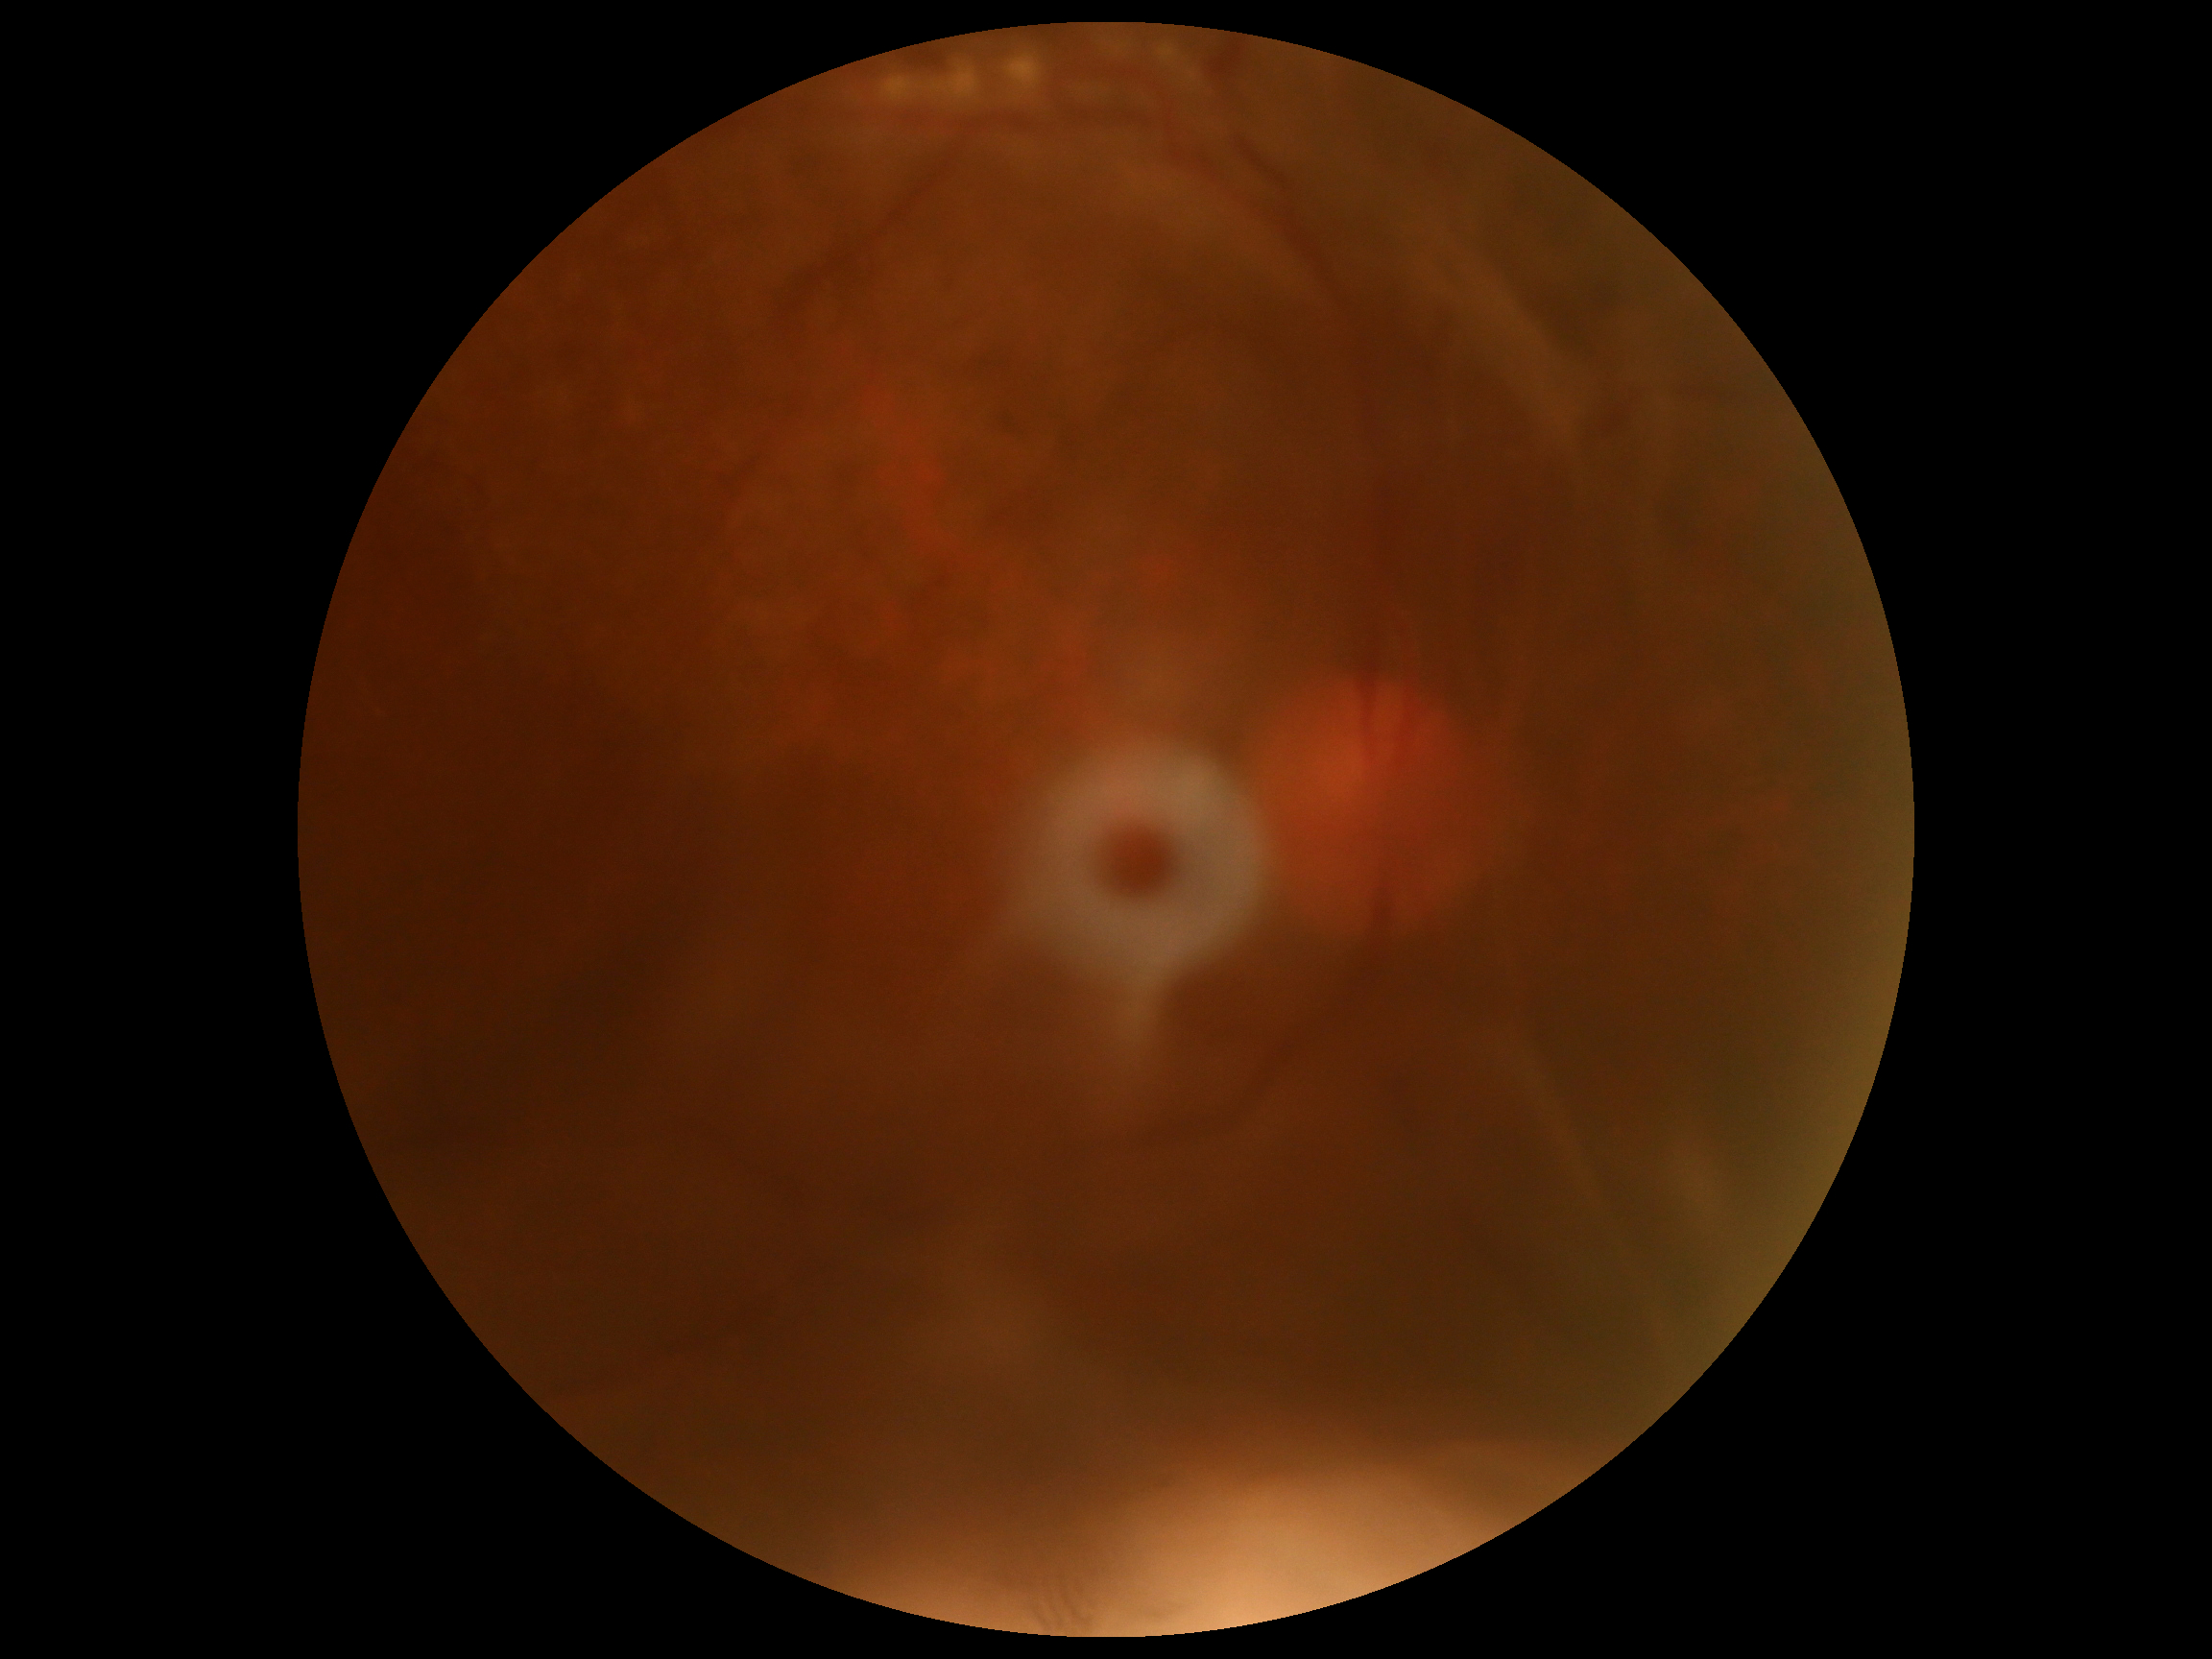   dr_grade: 4/4
  dr_category: proliferative diabetic retinopathy